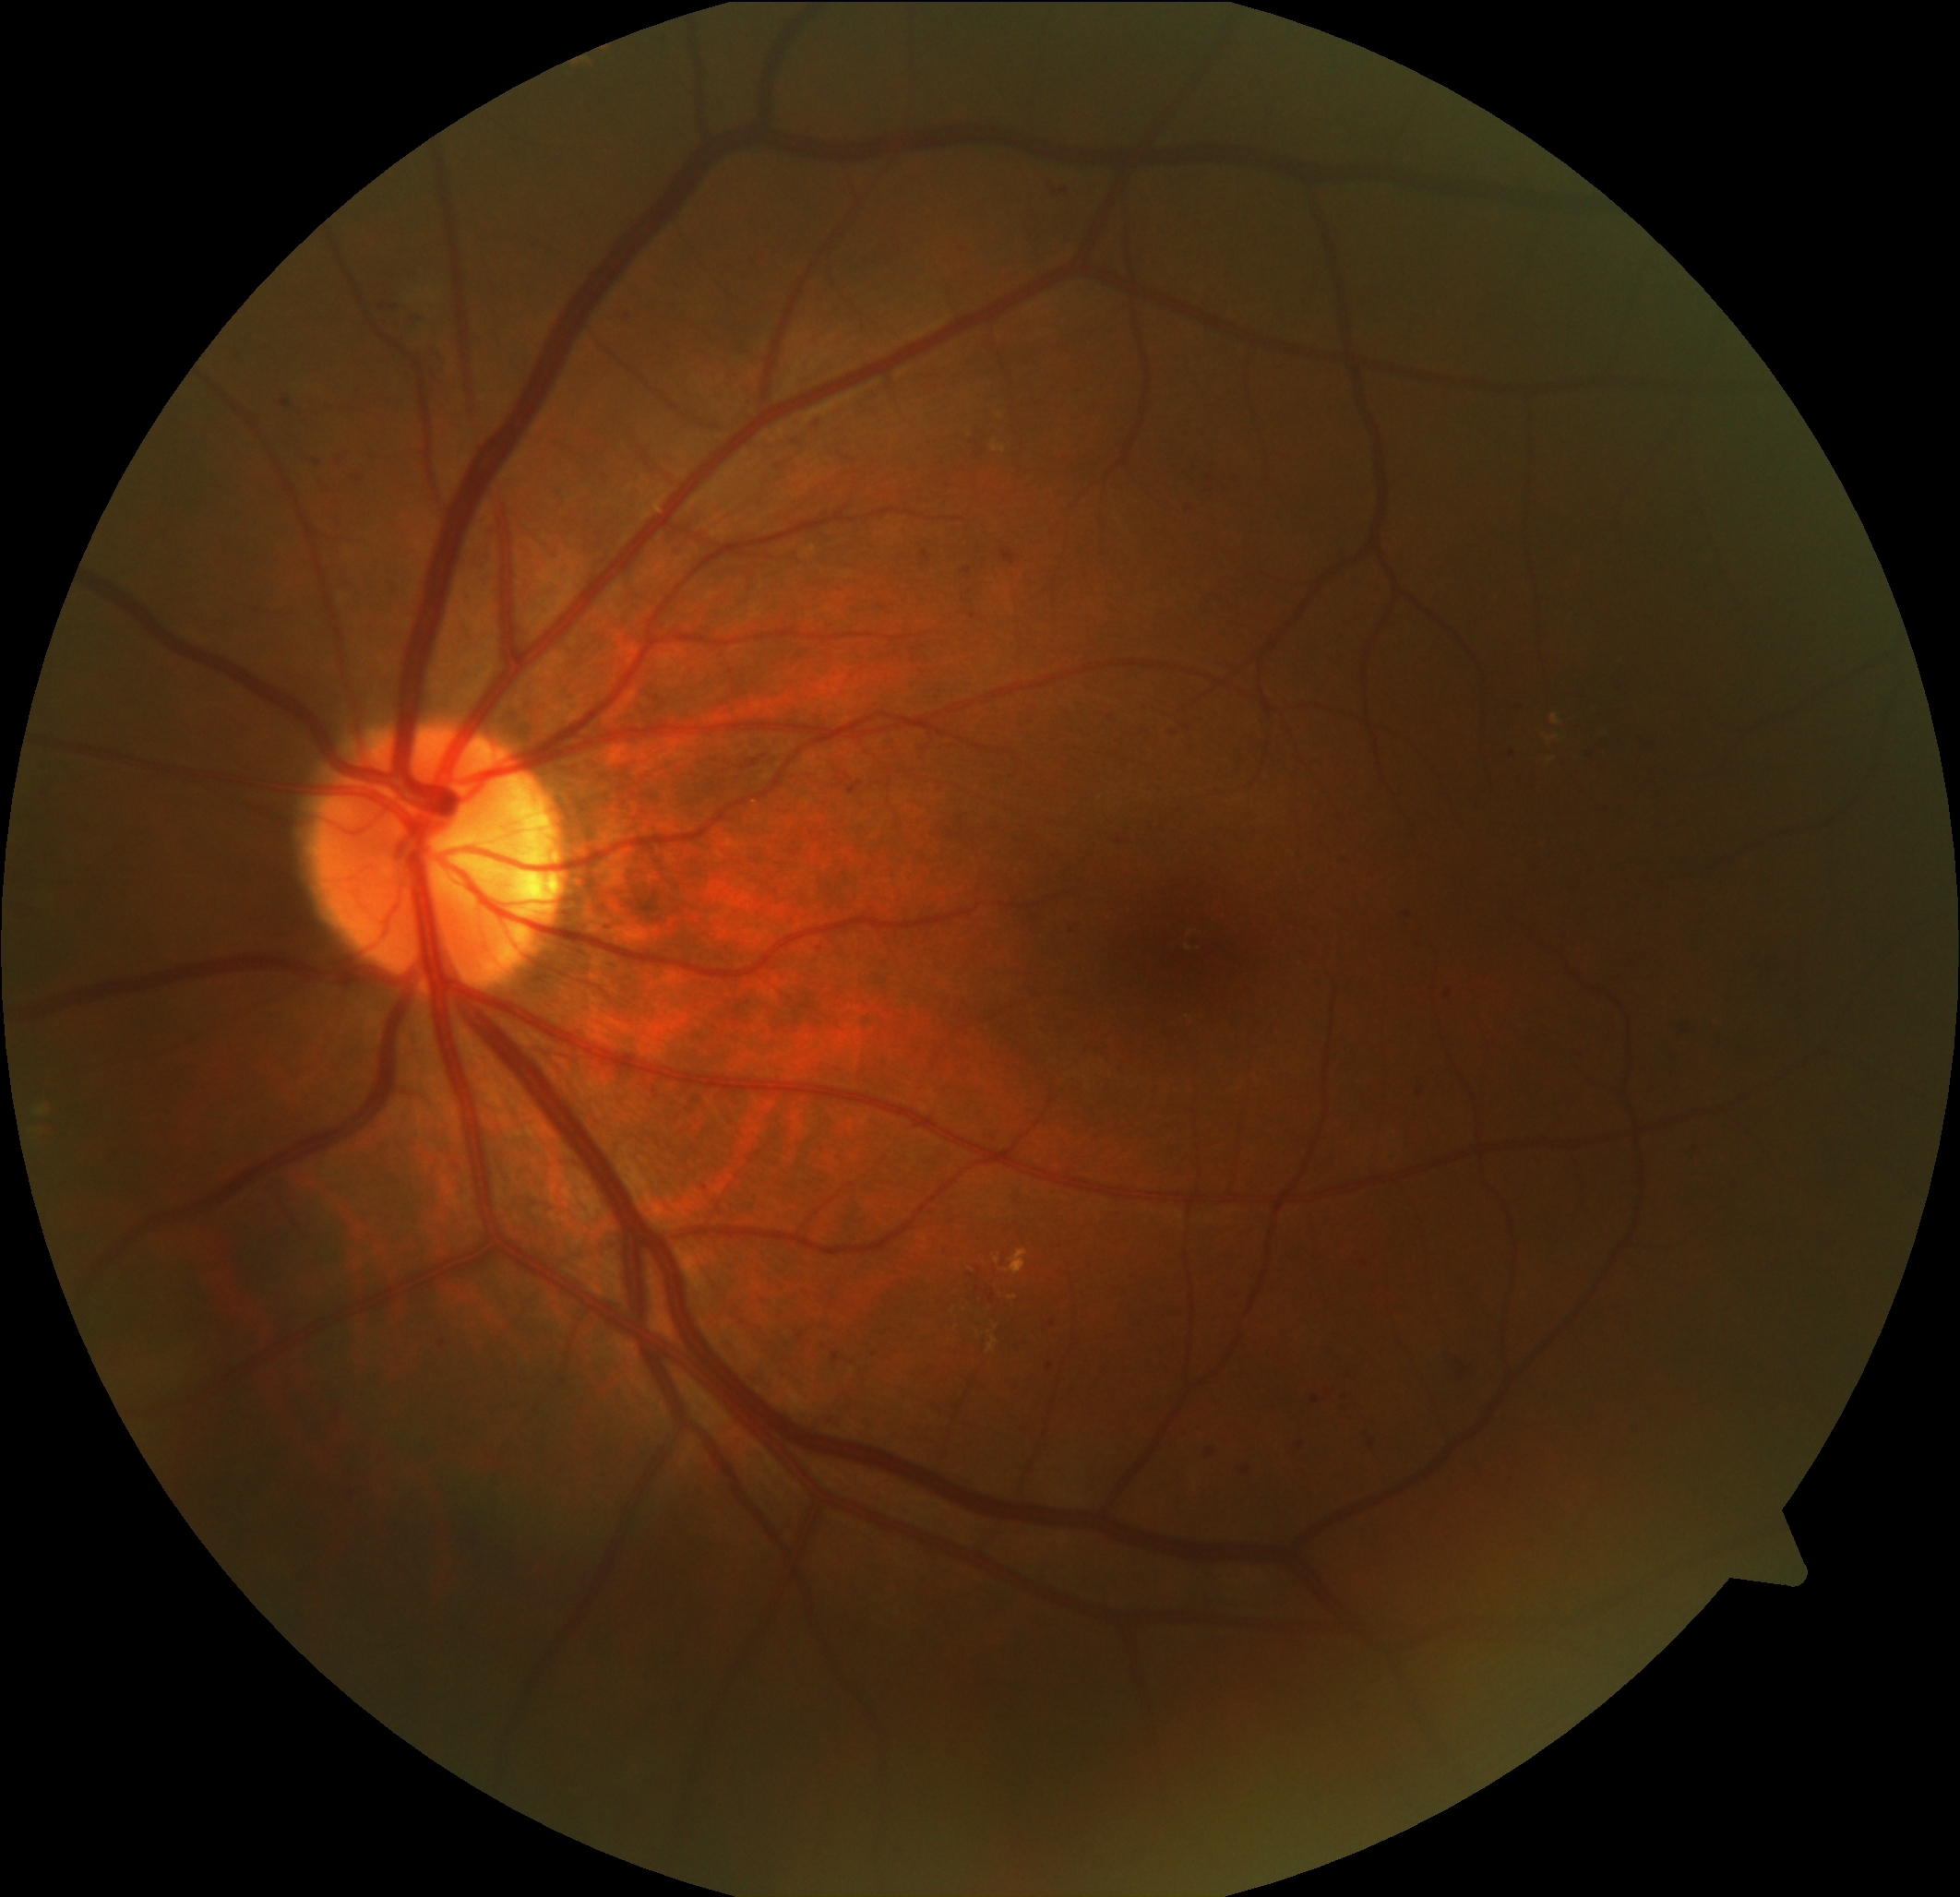
Diabetic retinopathy (DR) is grade 2 (moderate NPDR).